2352x1568. CFP. 45° field of view: 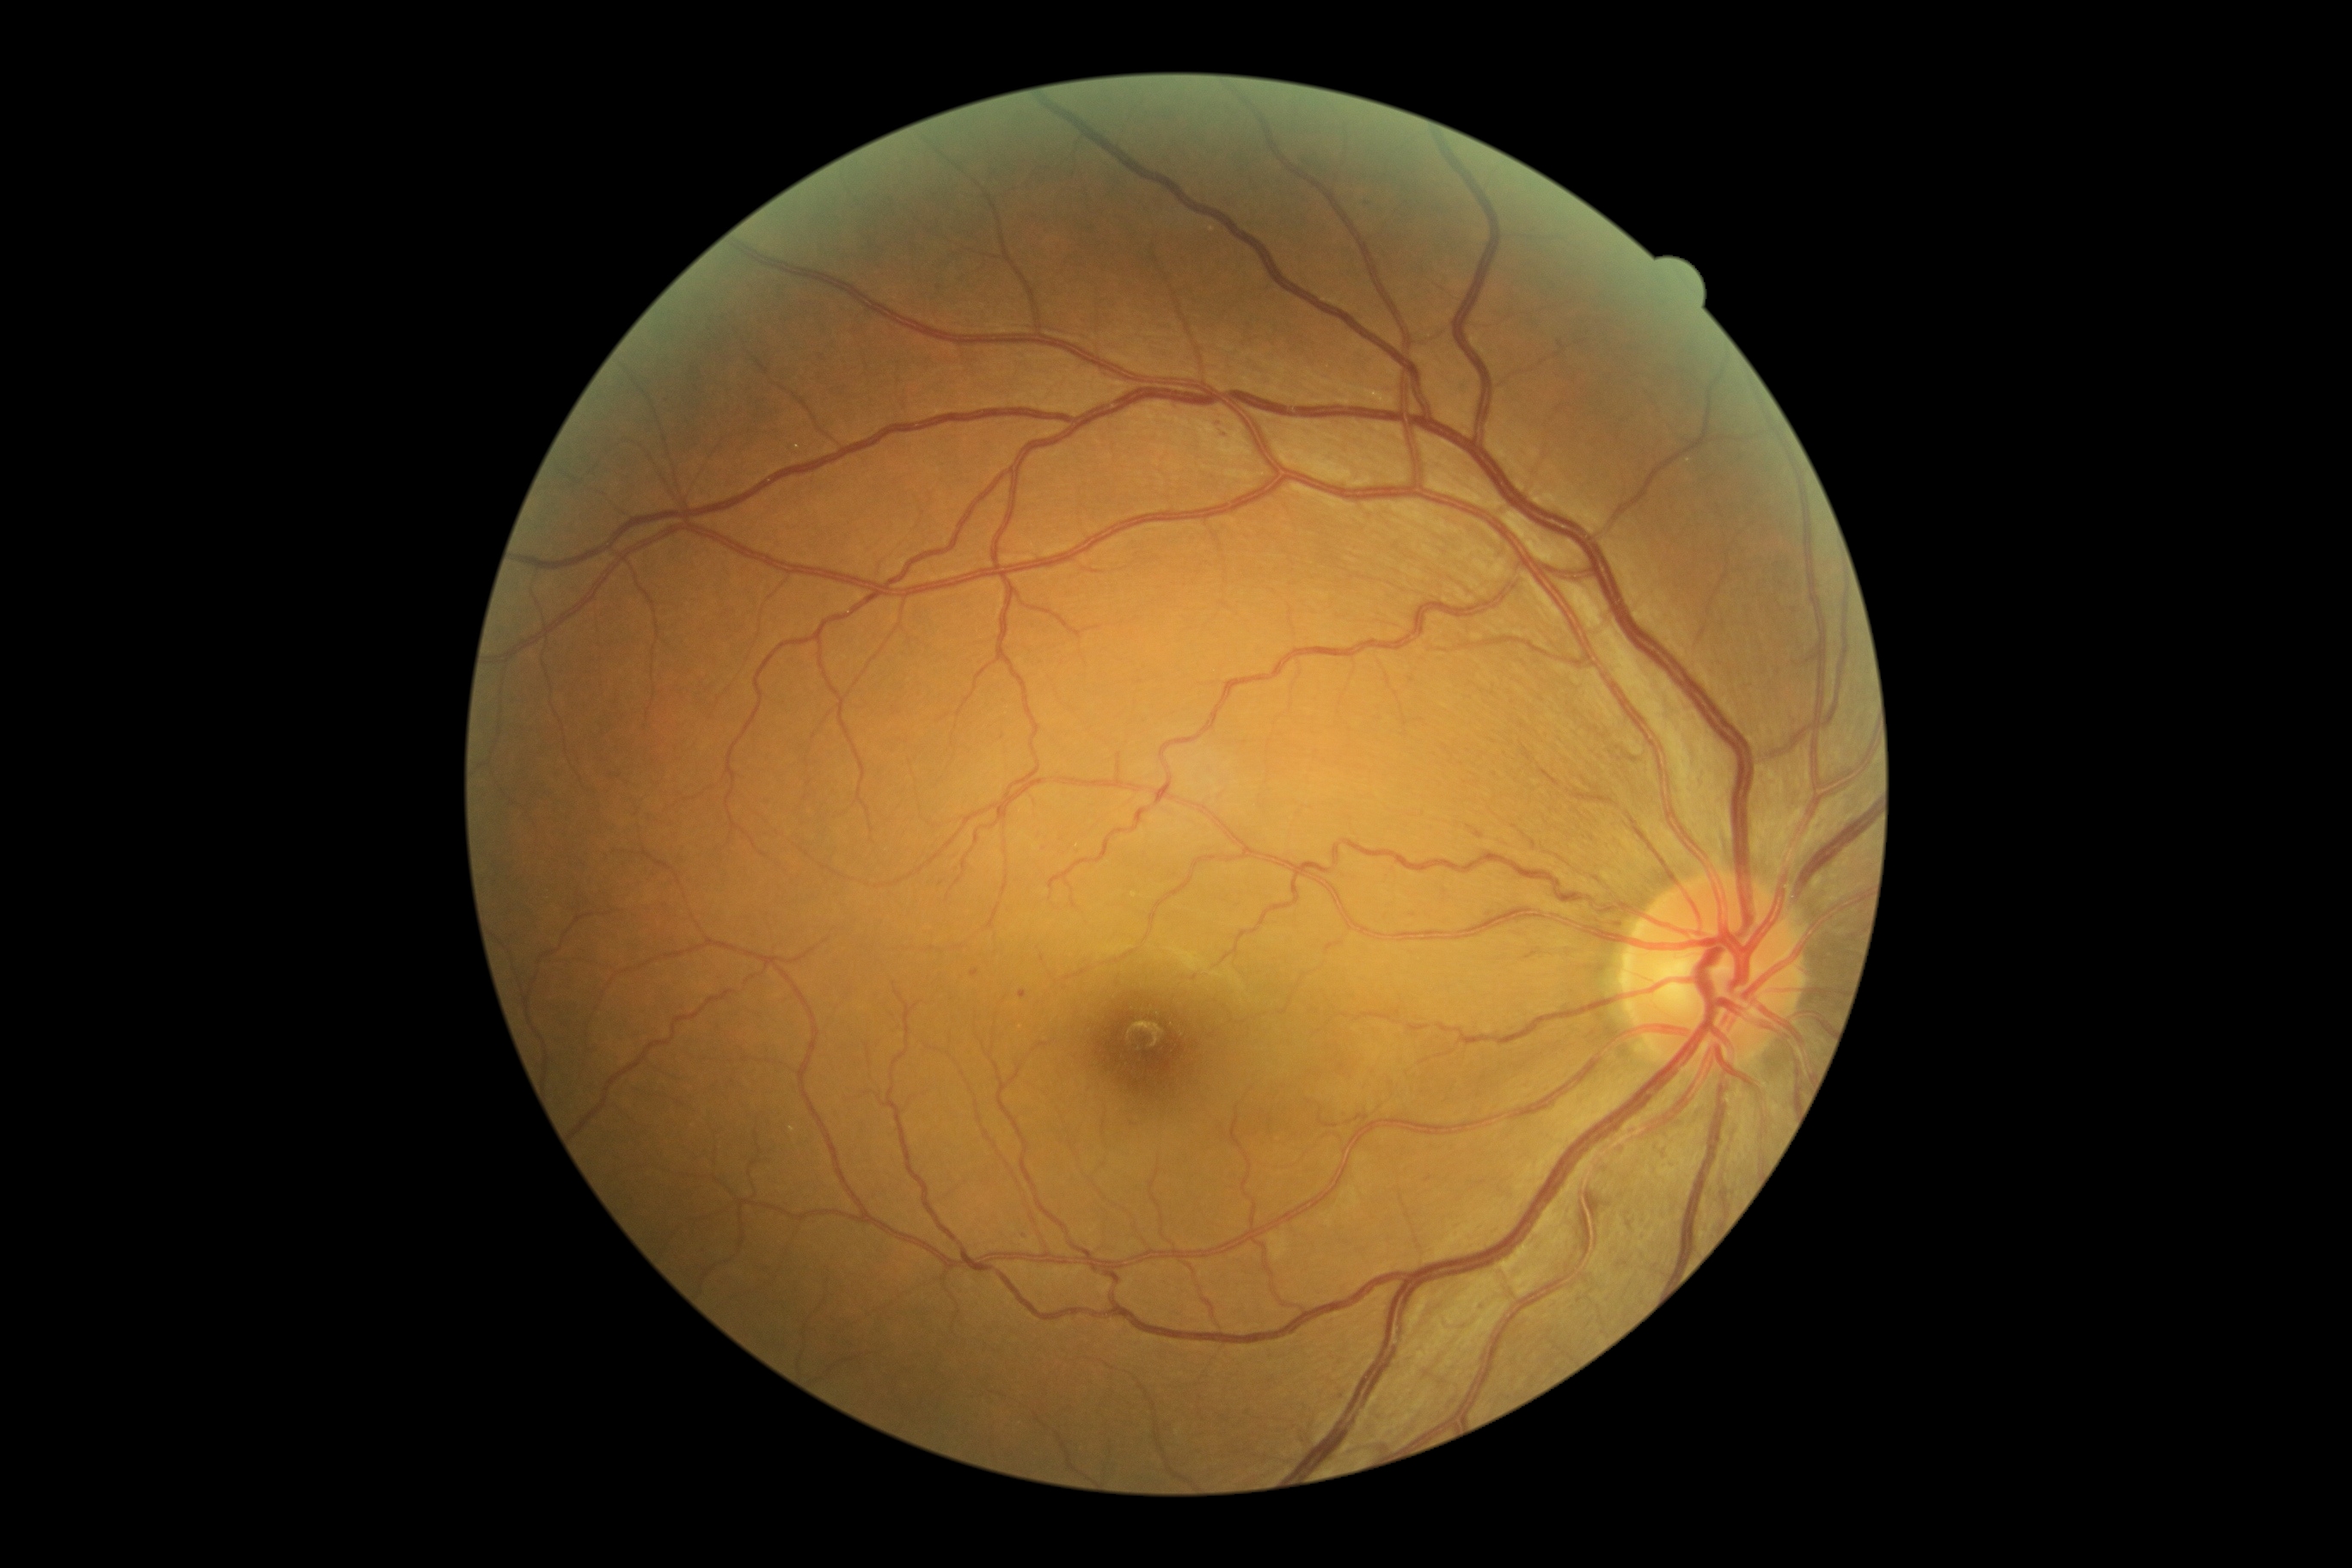 DR stage: grade 1 (mild NPDR) — presence of microaneurysms only. DR class: non-proliferative diabetic retinopathy.